Wide-field fundus photograph of an infant. 1440 x 1080 pixels
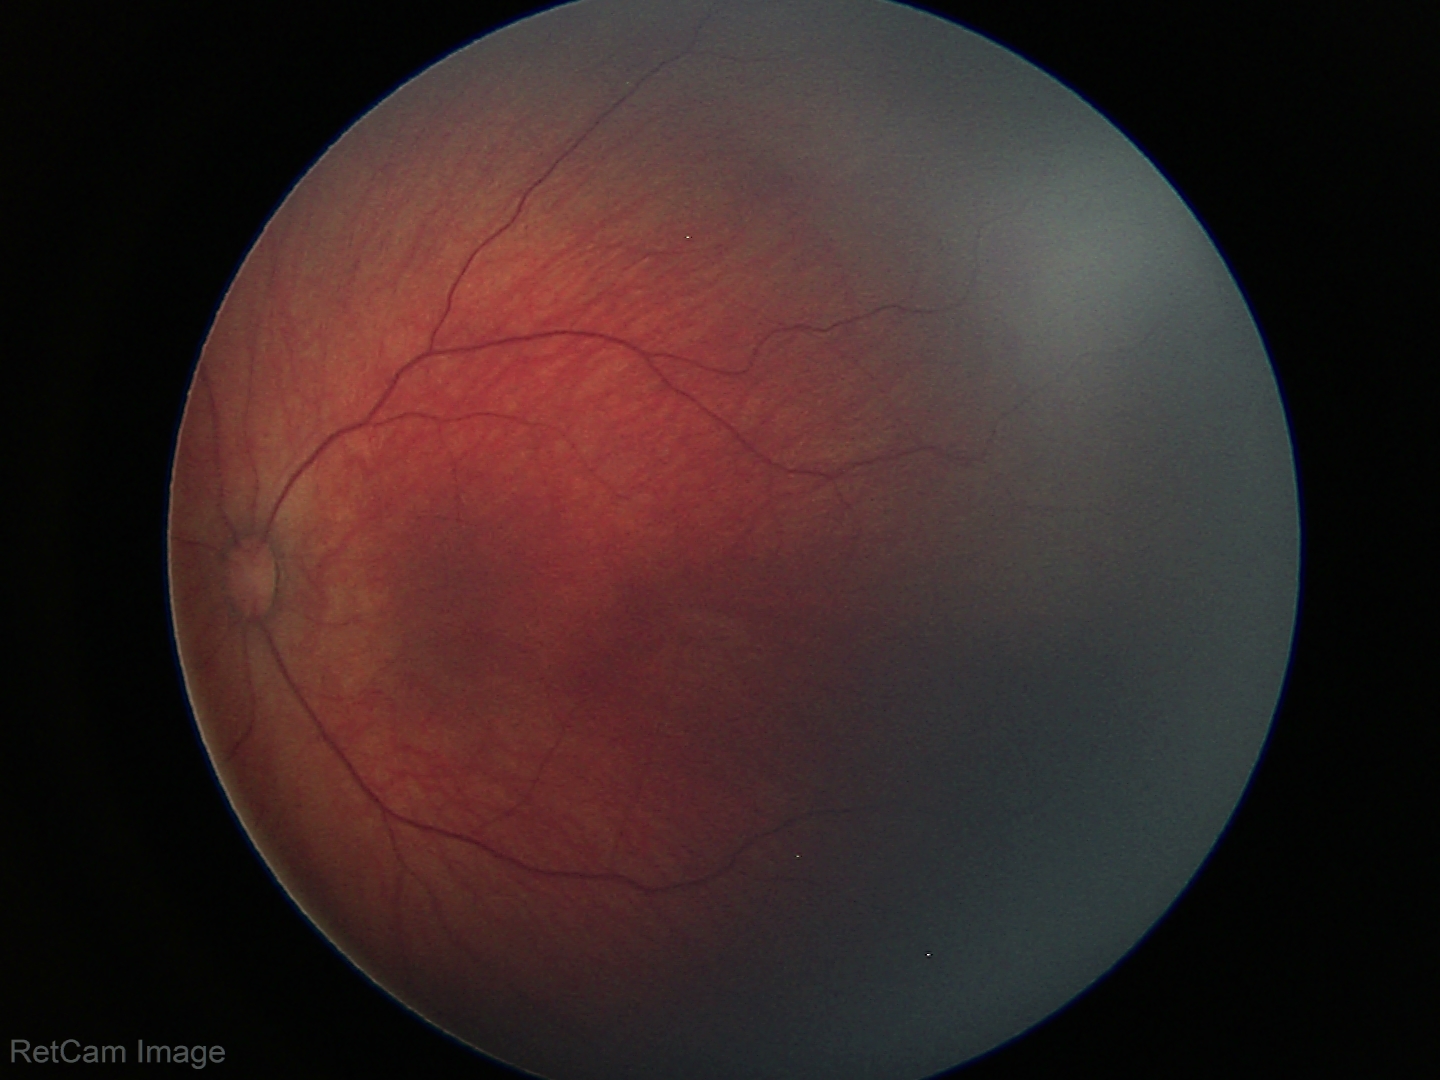

Screening examination consistent with retinal hemorrhages.